FOV: 45 degrees. Nonmydriatic — 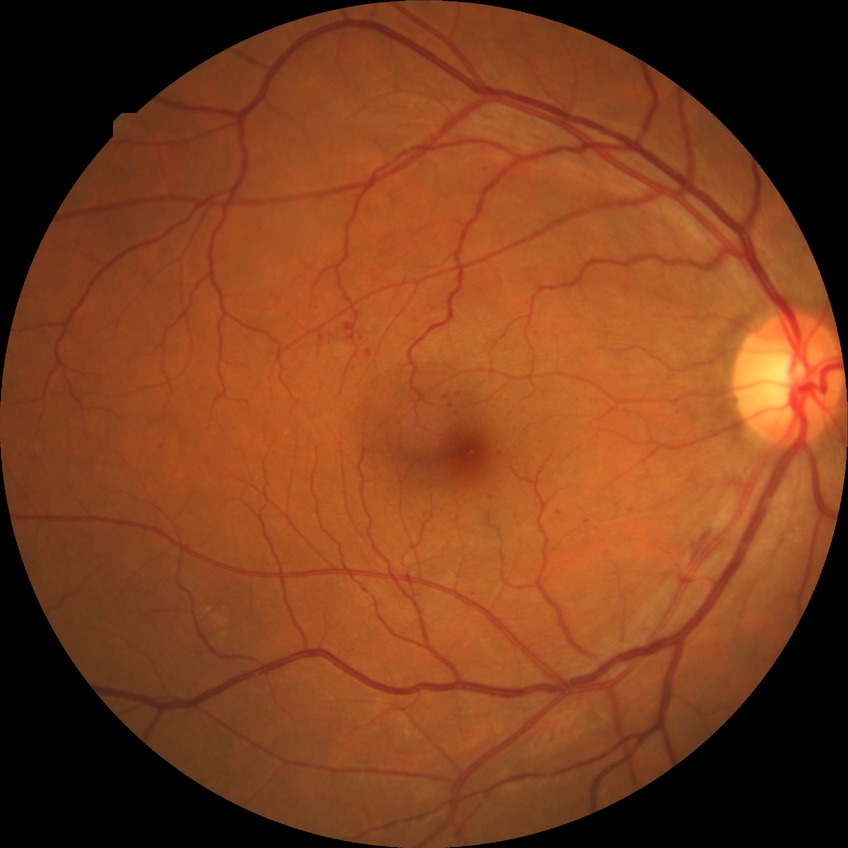 Davis stage: SDR.